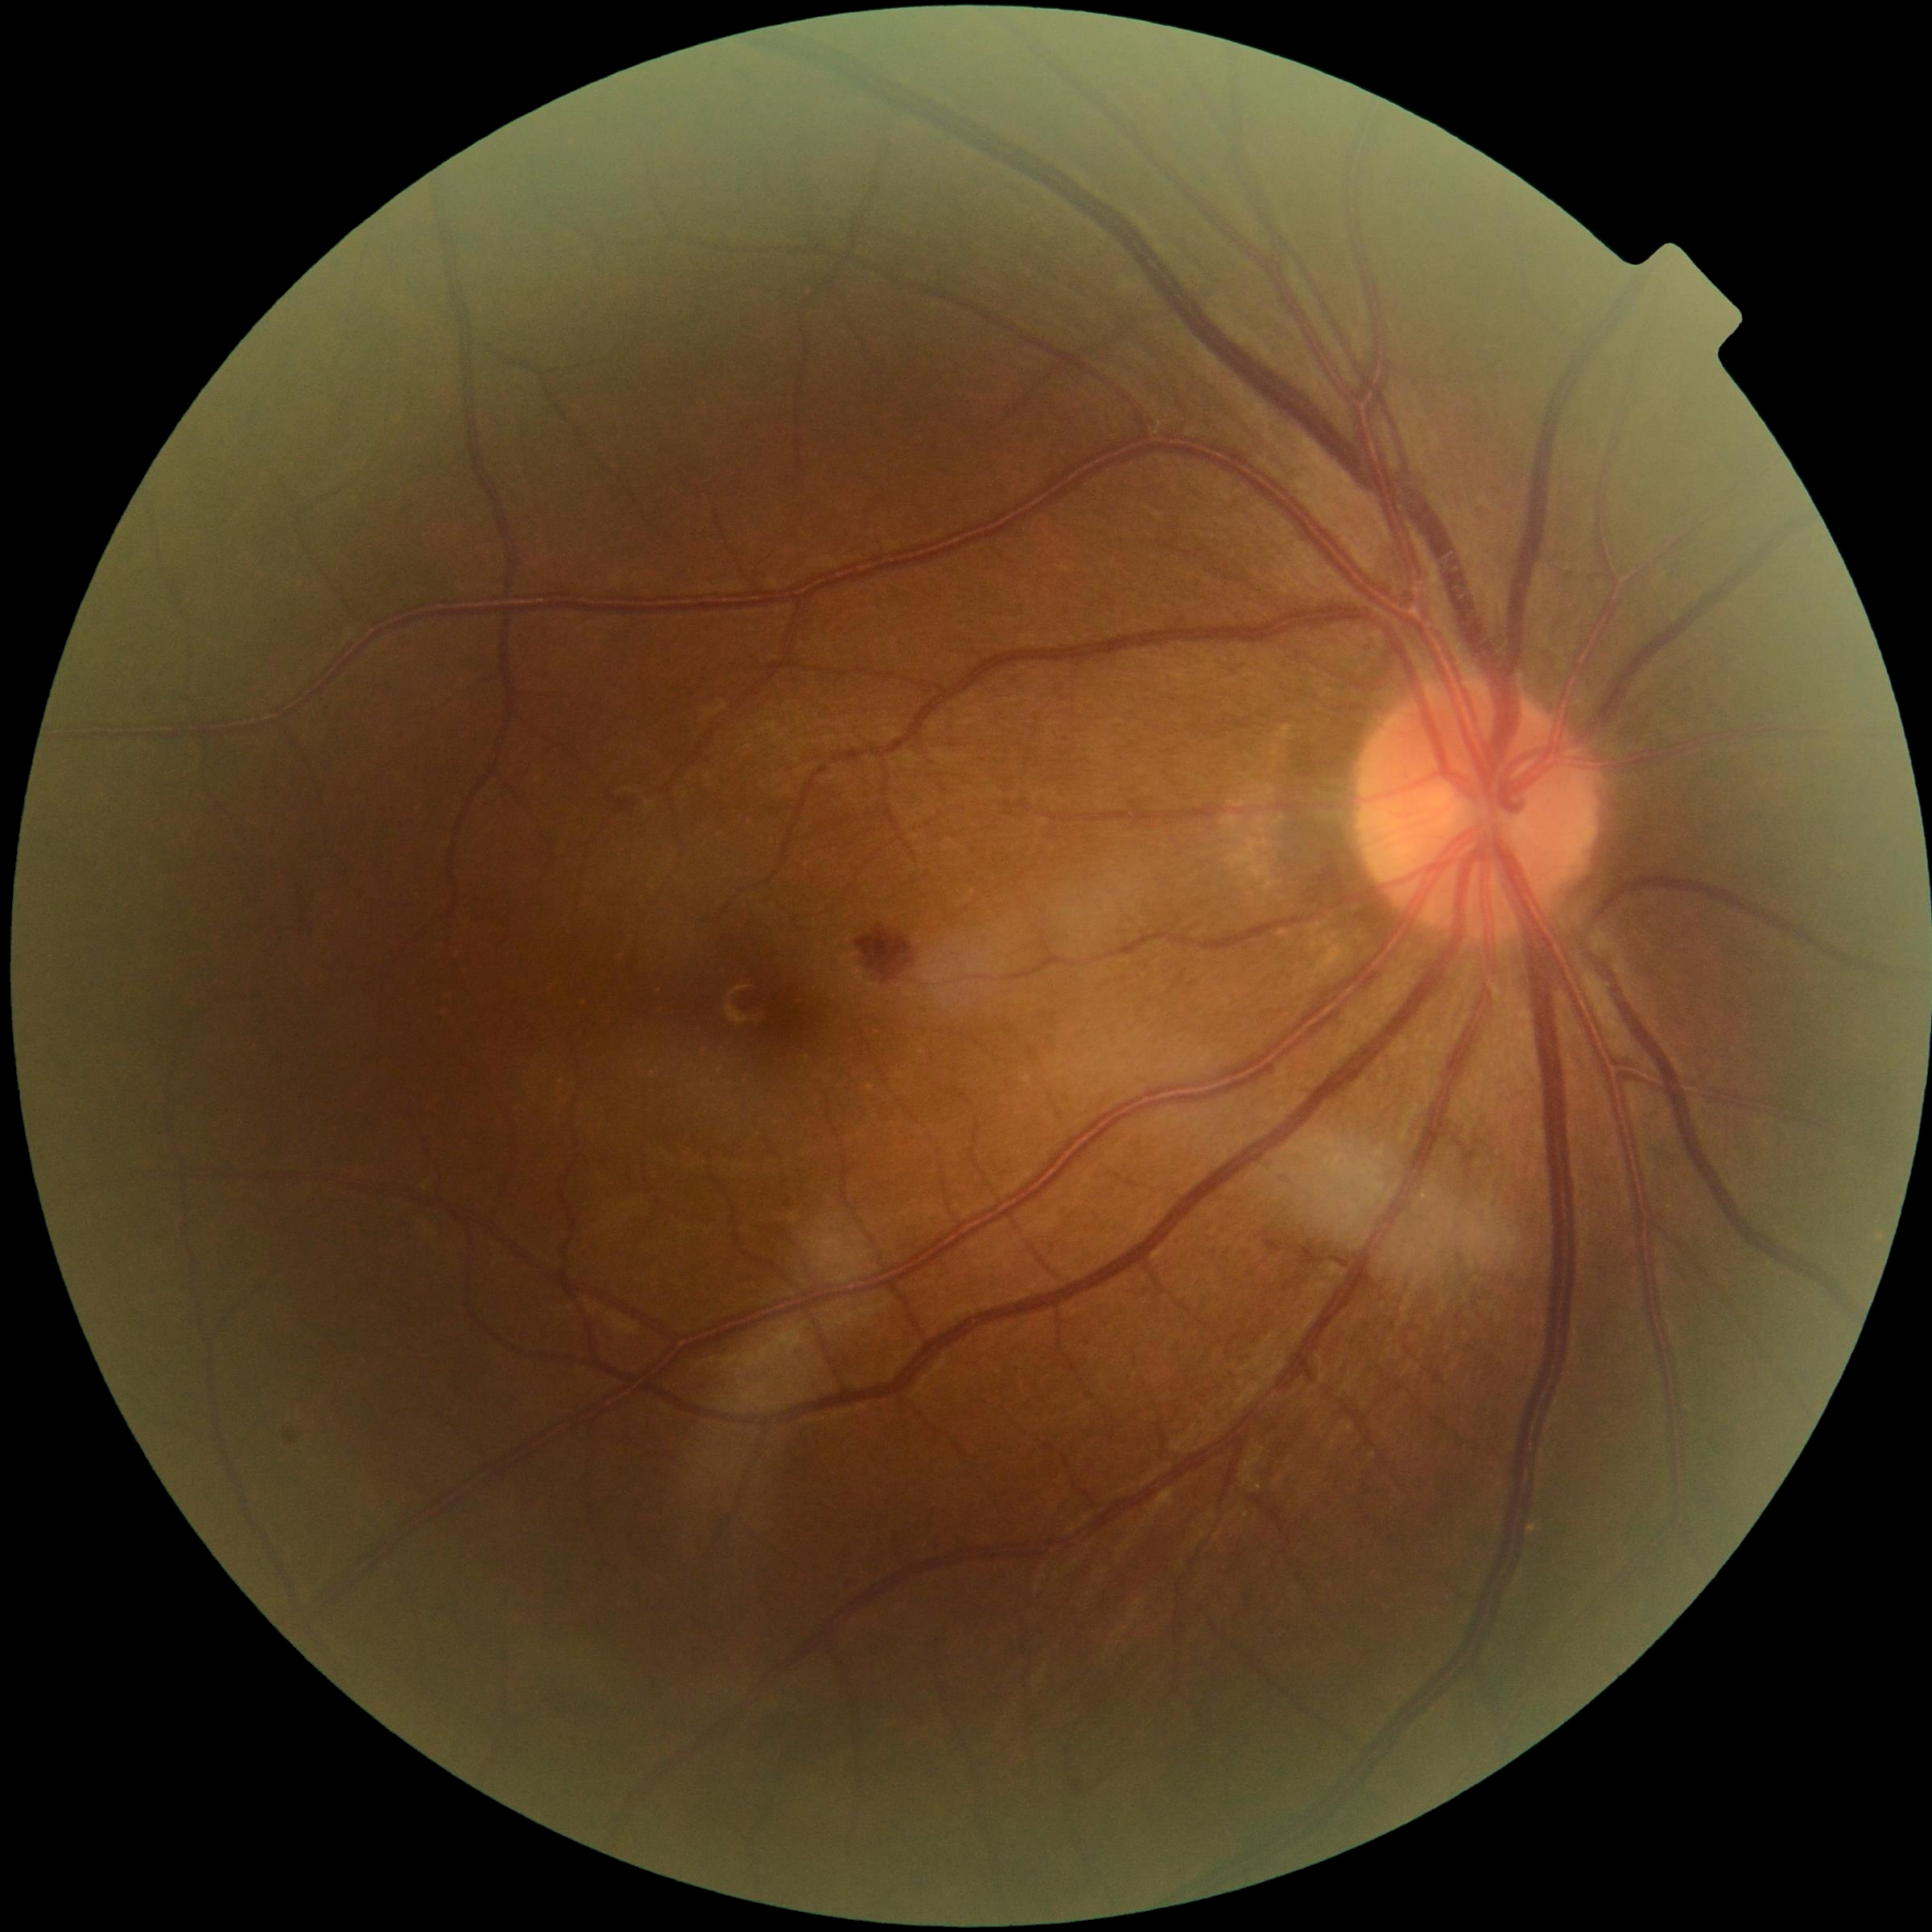

DR severity: grade 2 (moderate NPDR).